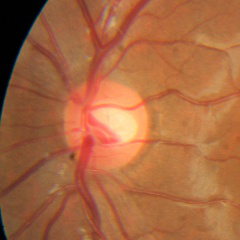 No glaucomatous optic neuropathy.